Wide-field fundus photograph from neonatal ROP screening; acquired on the Clarity RetCam 3; 640x480px
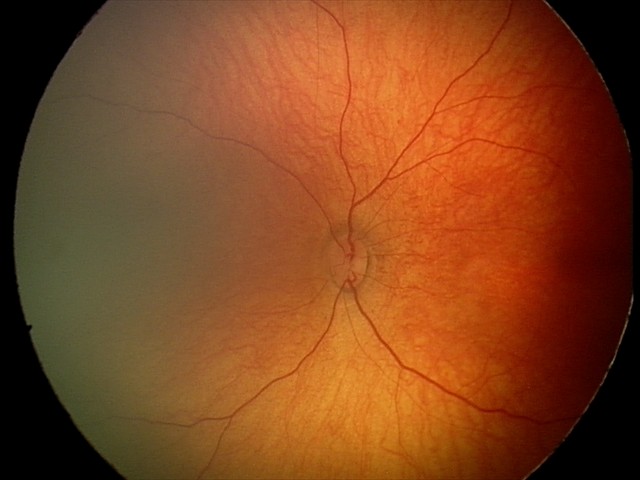 No retinal pathology identified on screening.